1240 x 1240 pixels · pediatric wide-field fundus photograph: 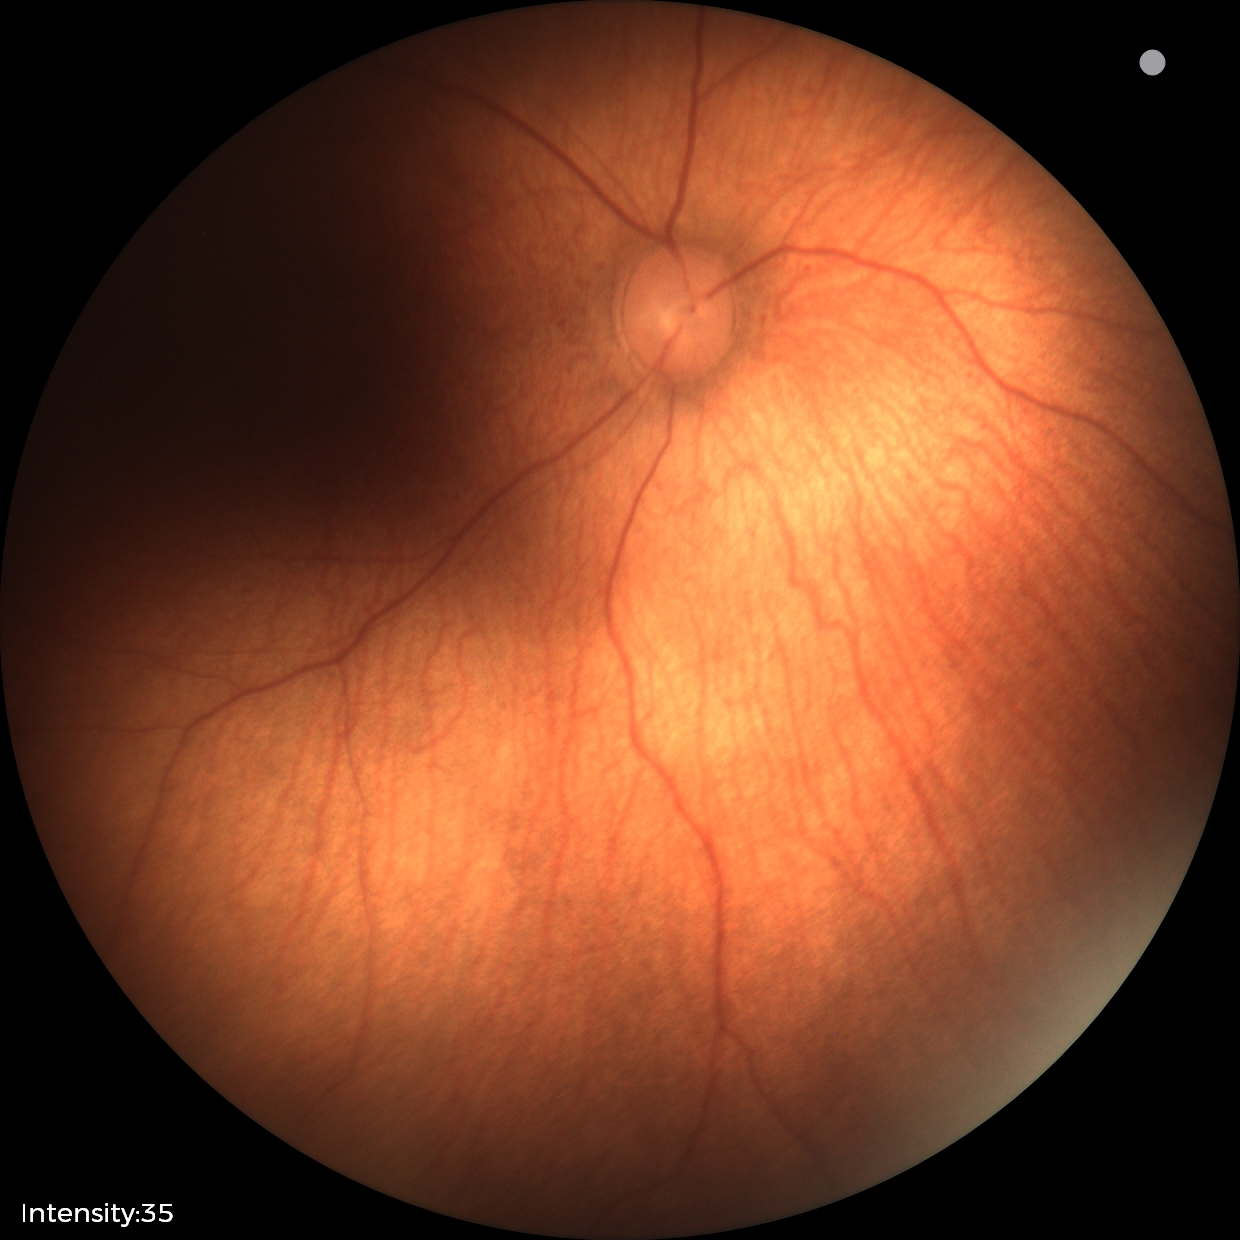

Screening examination diagnosed as physiological.